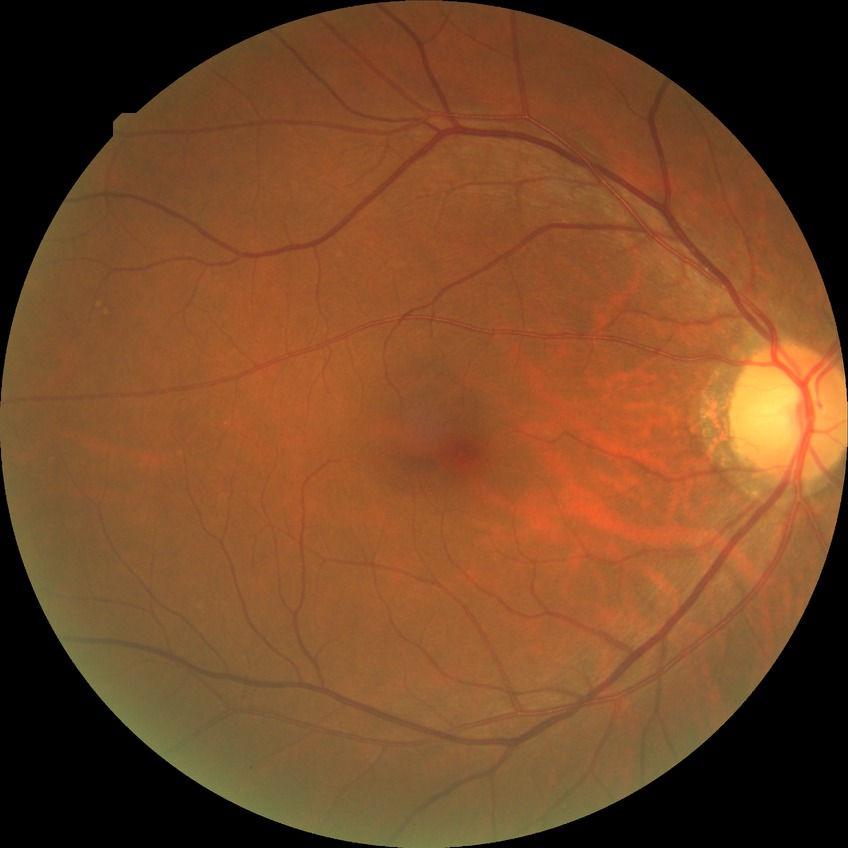

Davis grade: NDR.
No apparent diabetic retinopathy.